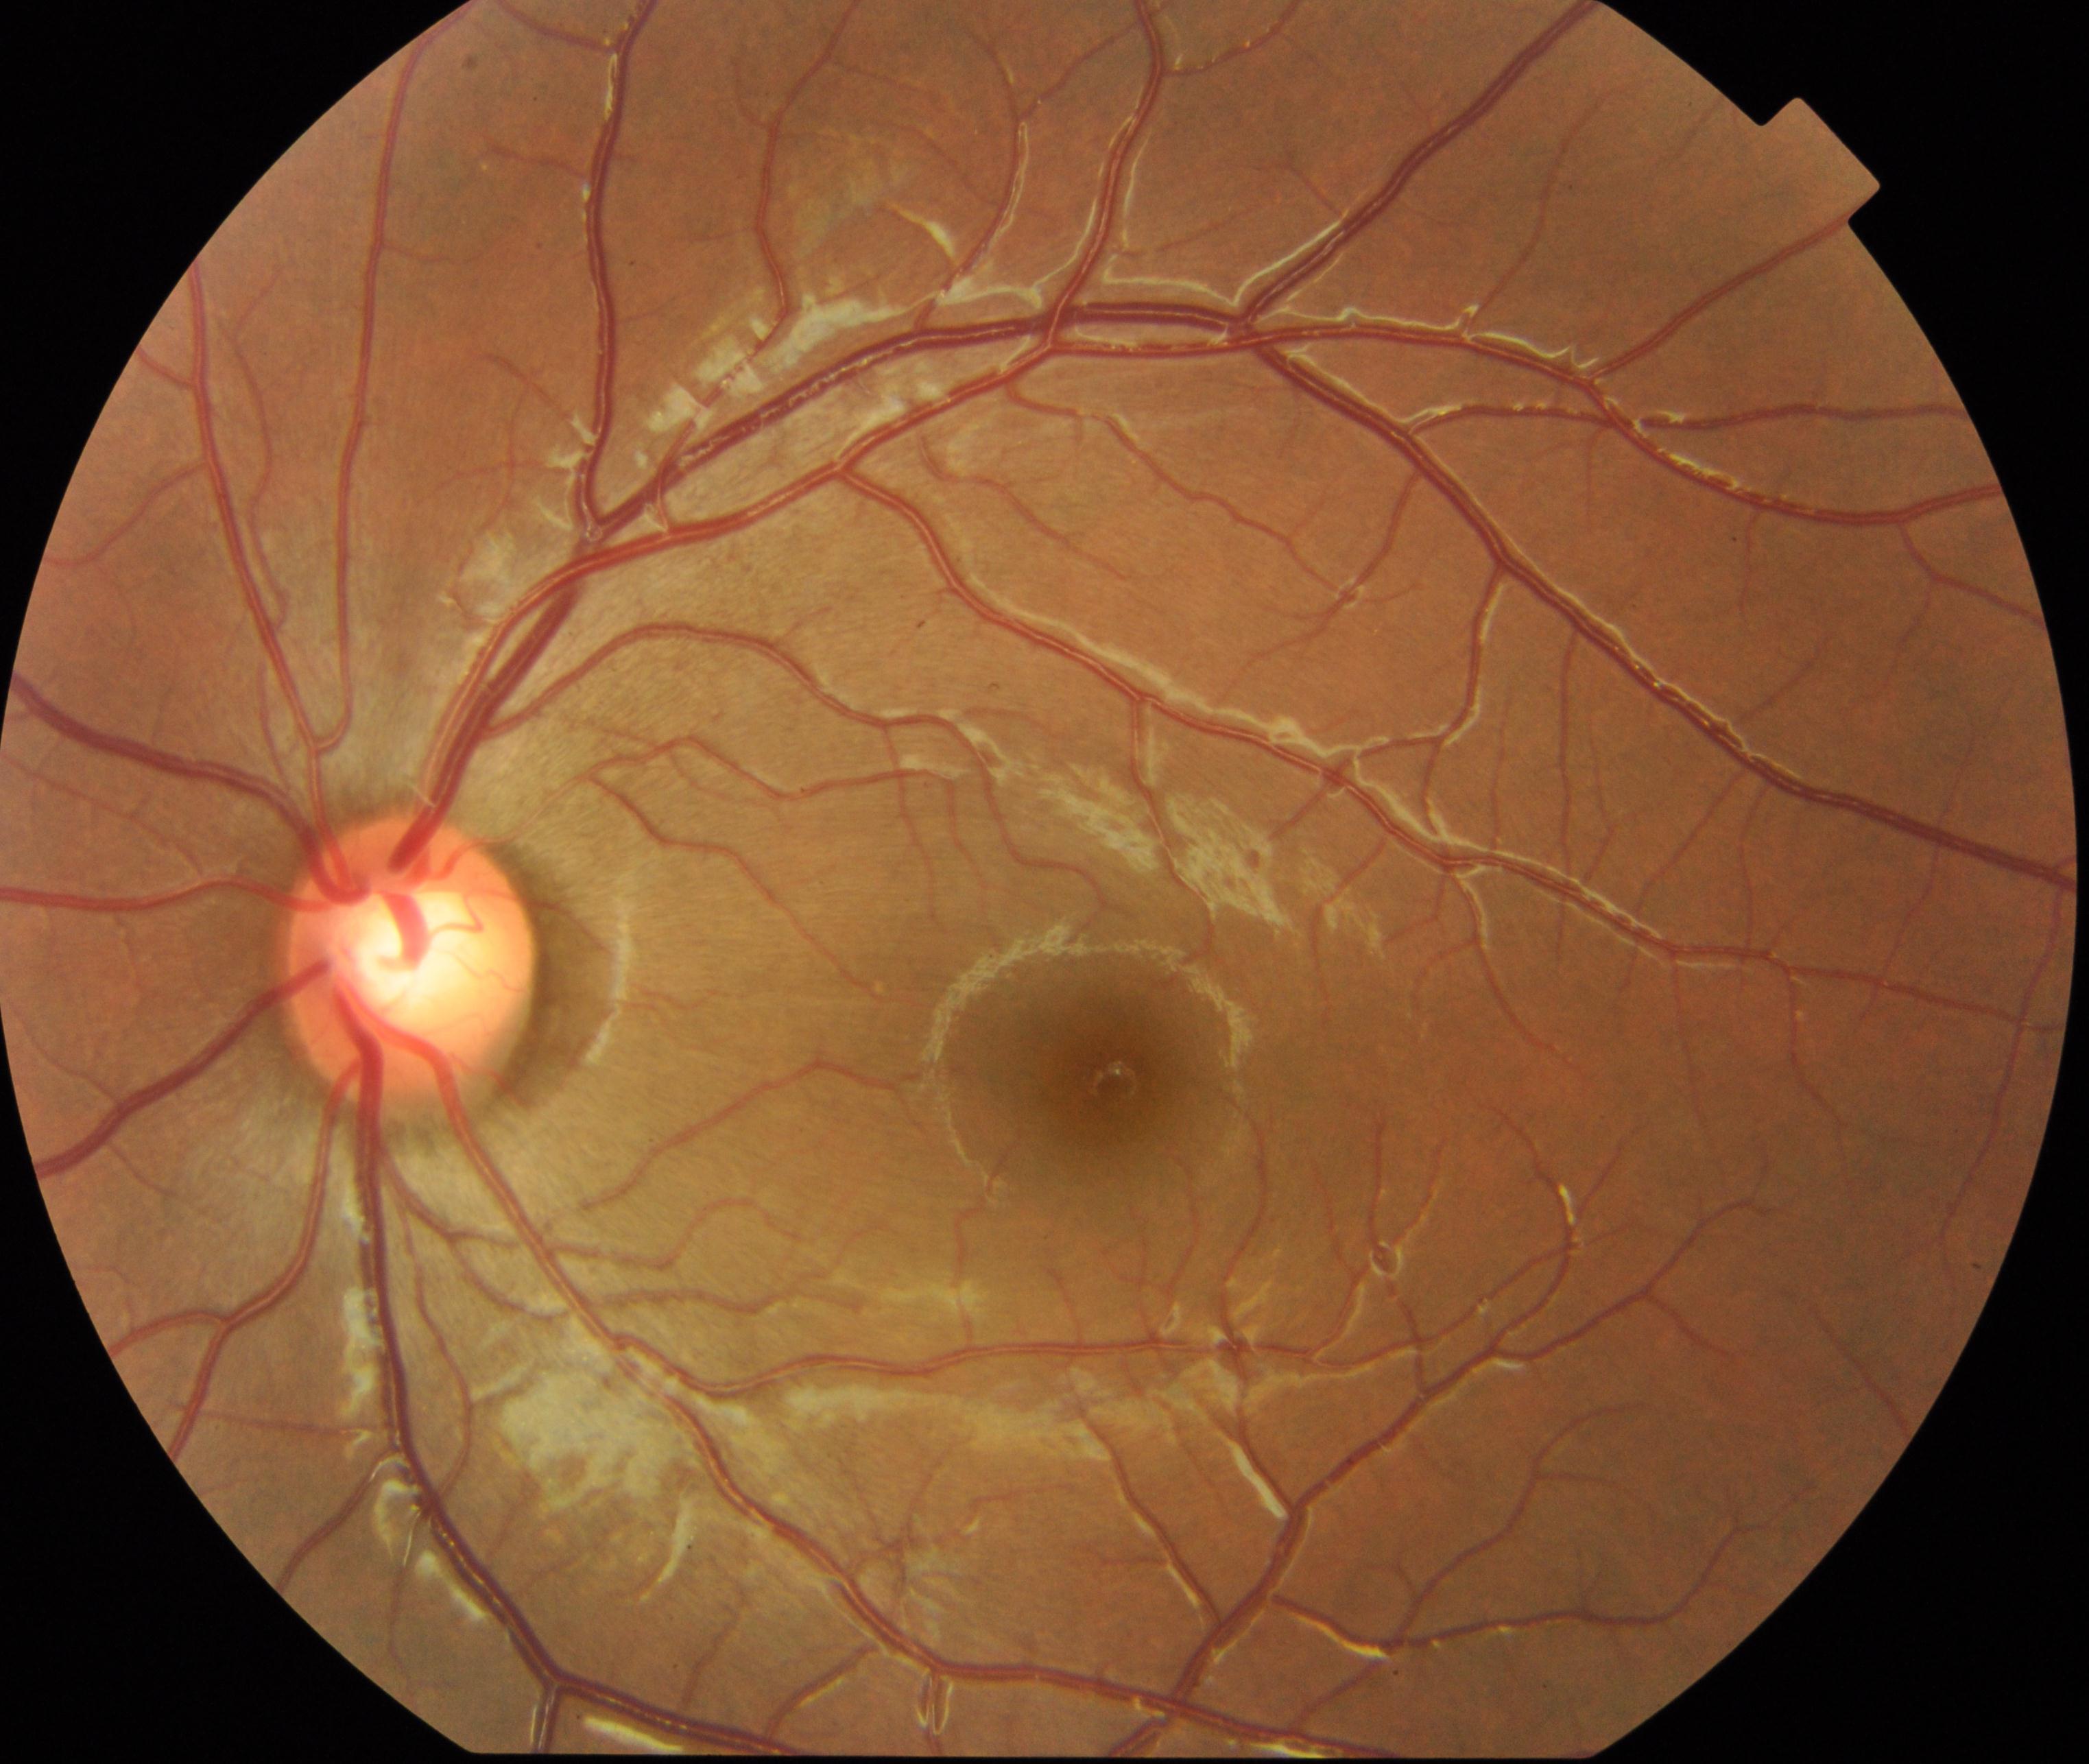 Findings consistent with large optic cup.